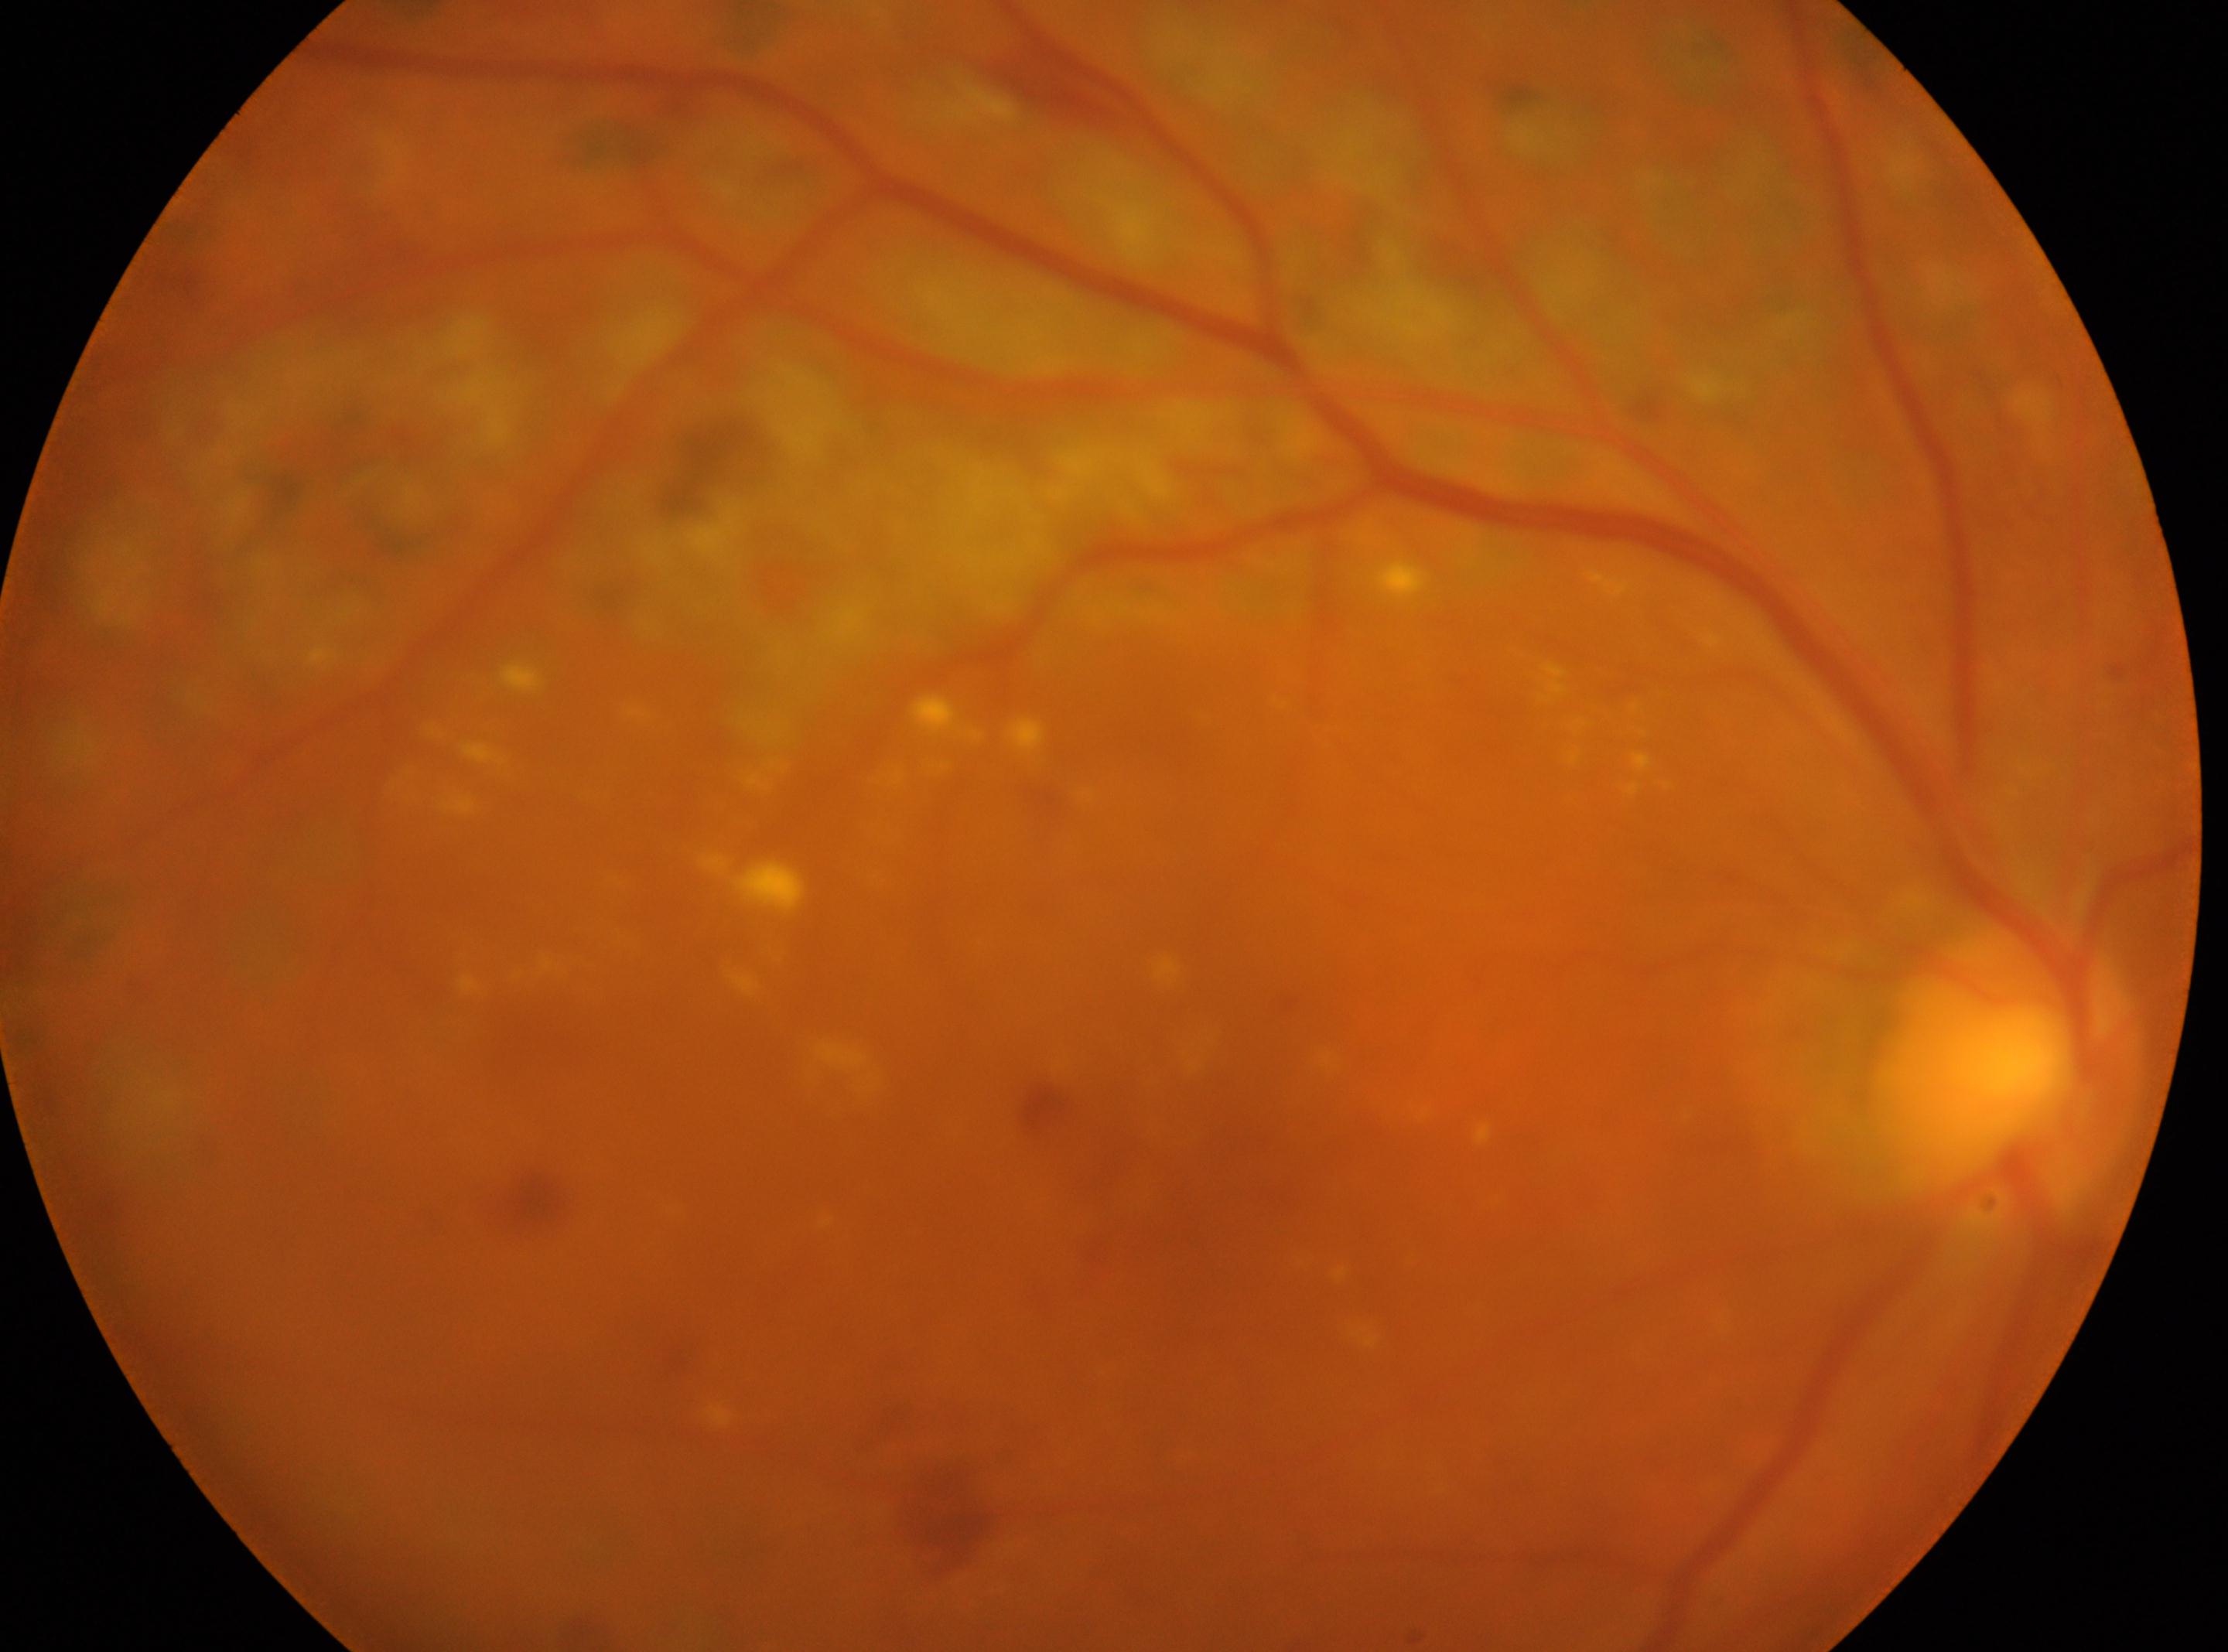
fovea: [1224, 1140]
OD
optic disk: [2007, 1072]
DR severity: DR with laser spots or scars, reclassified as moderate NPDR (grade 2)